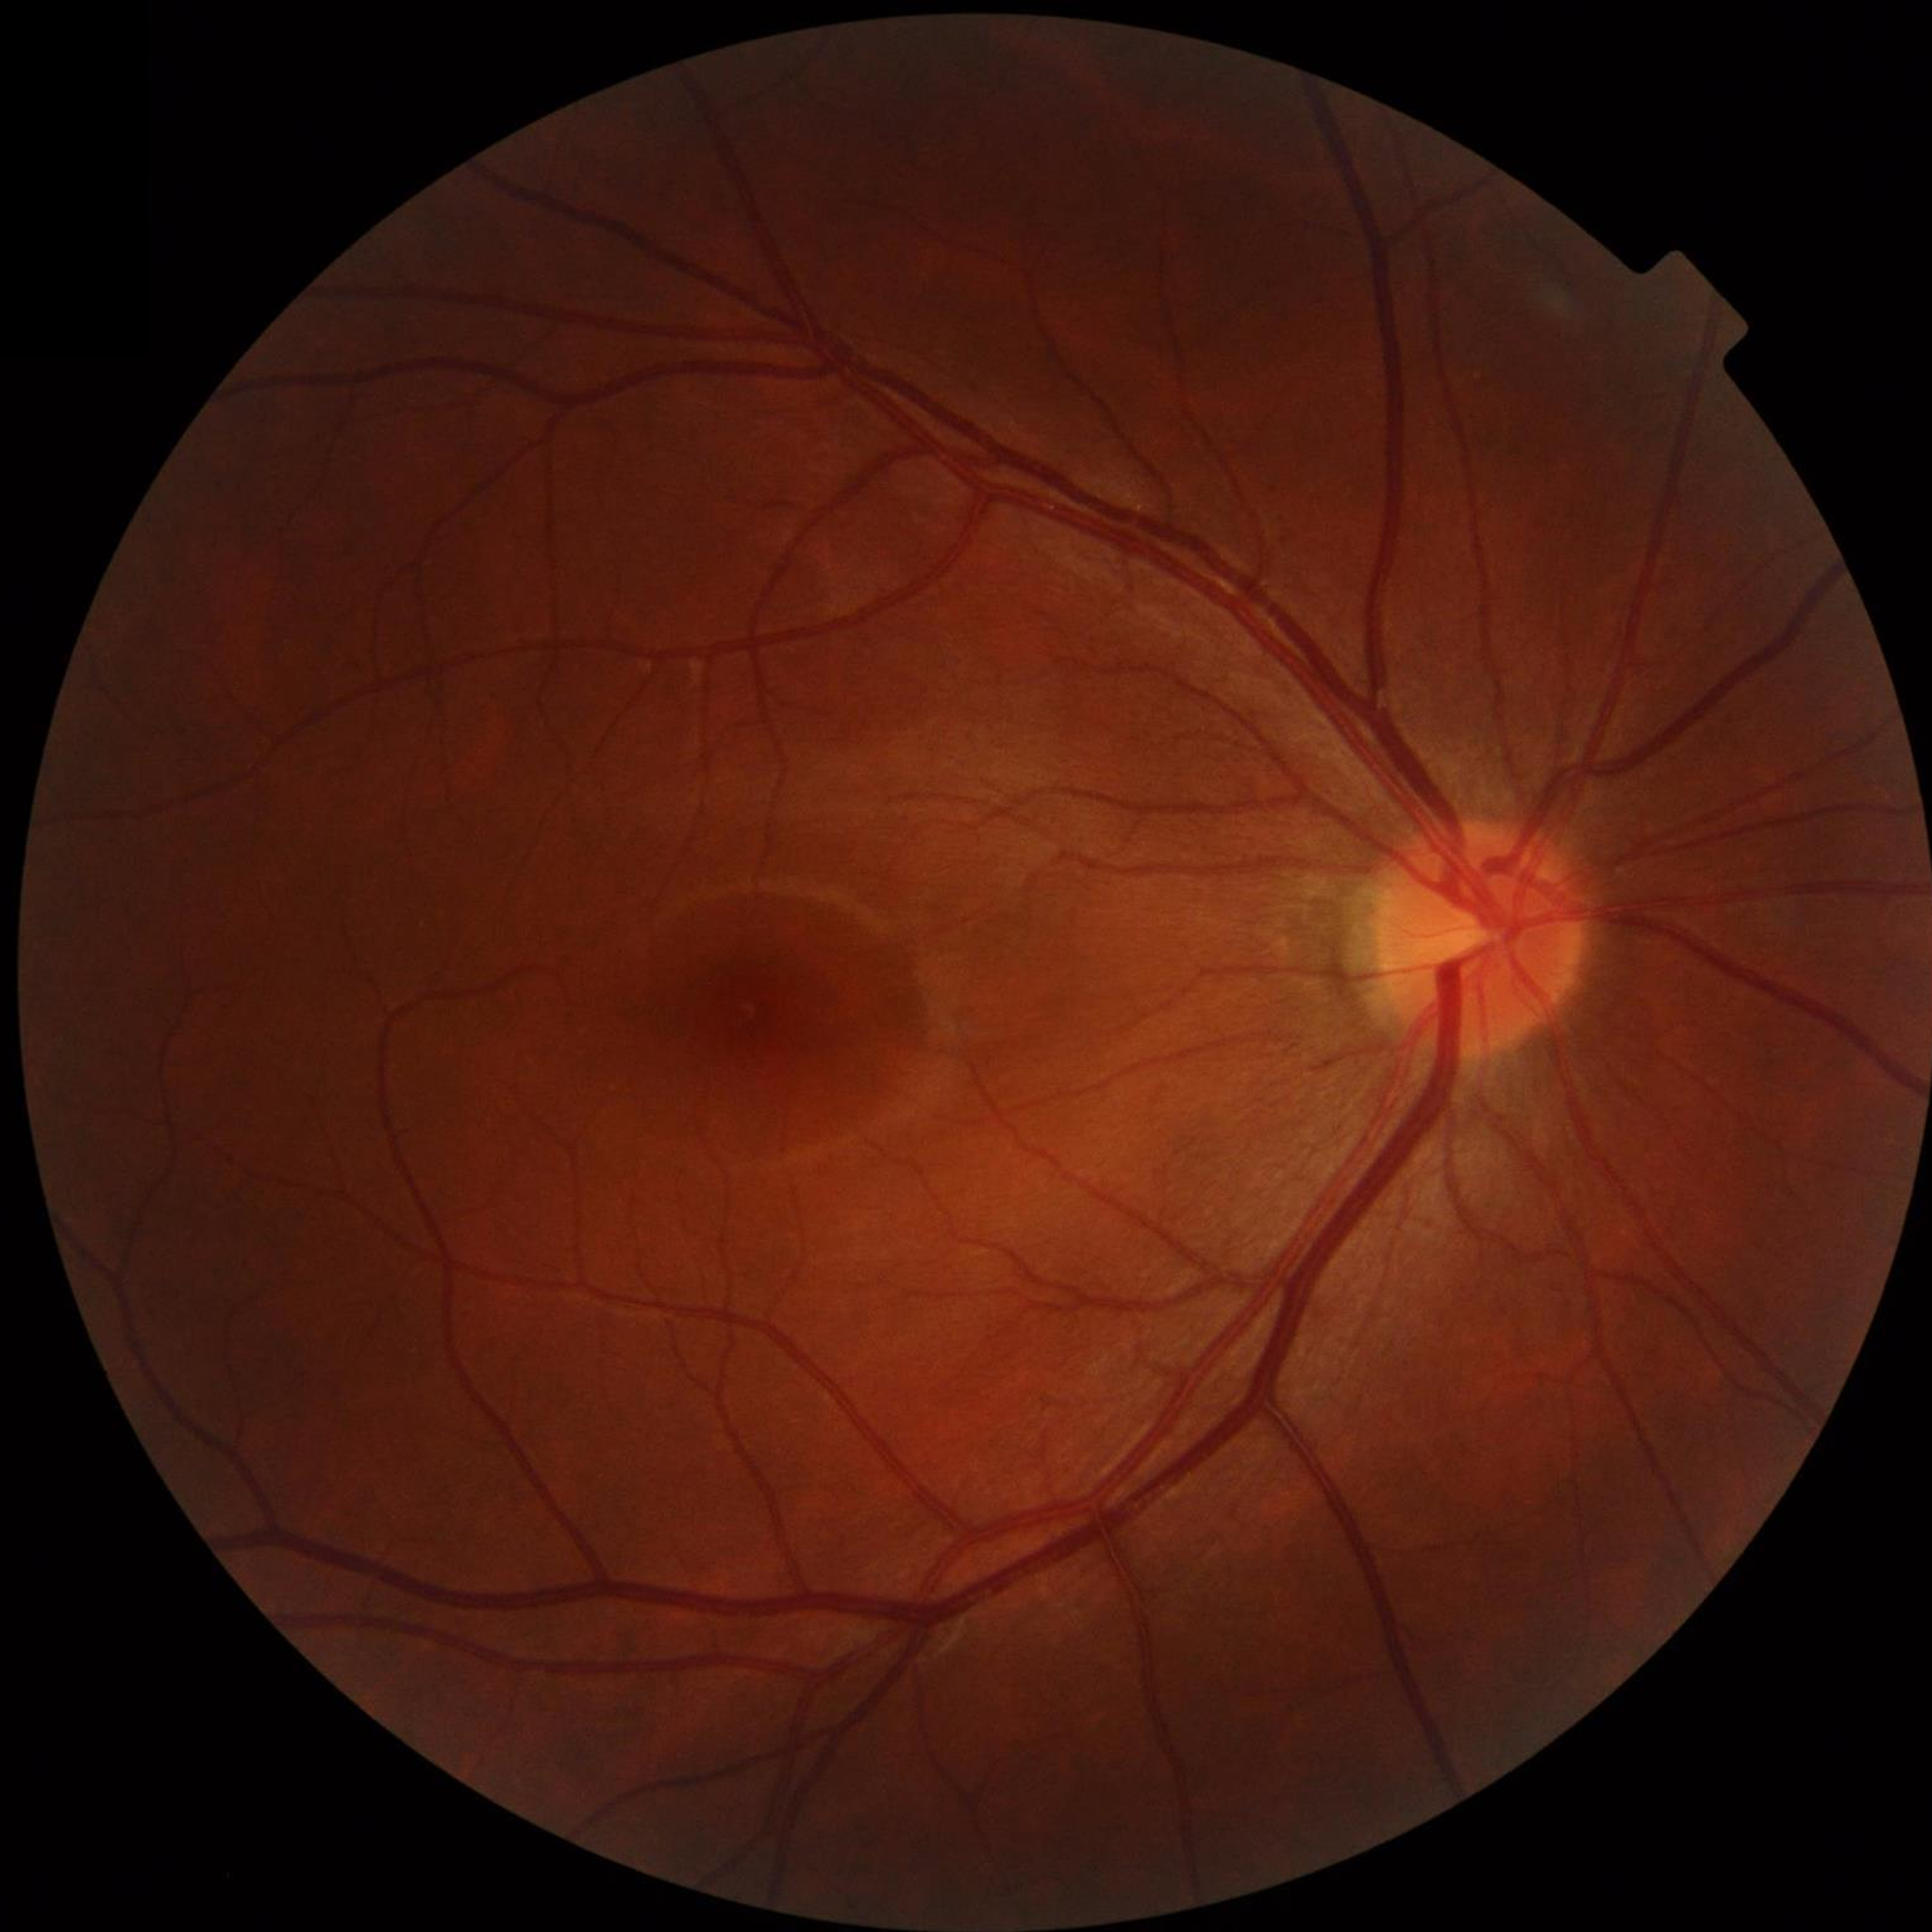
Control patient without diagnosed AMD, DR, or glaucoma.